848x848, nonmydriatic, modified Davis grading, 45-degree field of view, fundus photo — 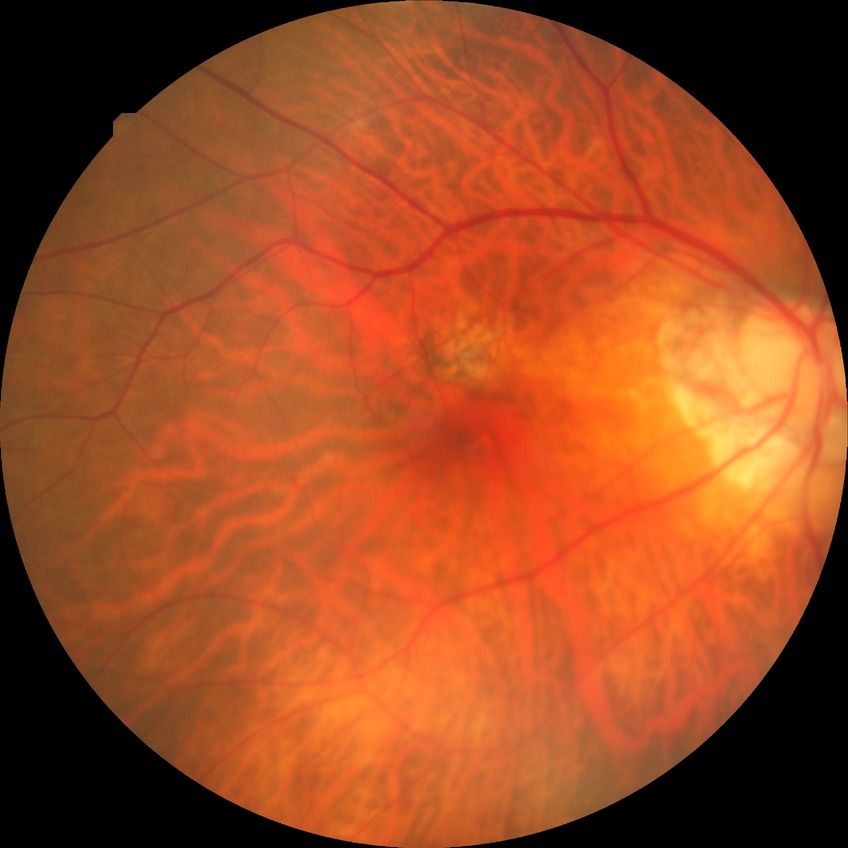 Diabetic retinopathy (DR) is NDR (no diabetic retinopathy).